848x848px. Retinal fundus photograph. Graded on the modified Davis scale
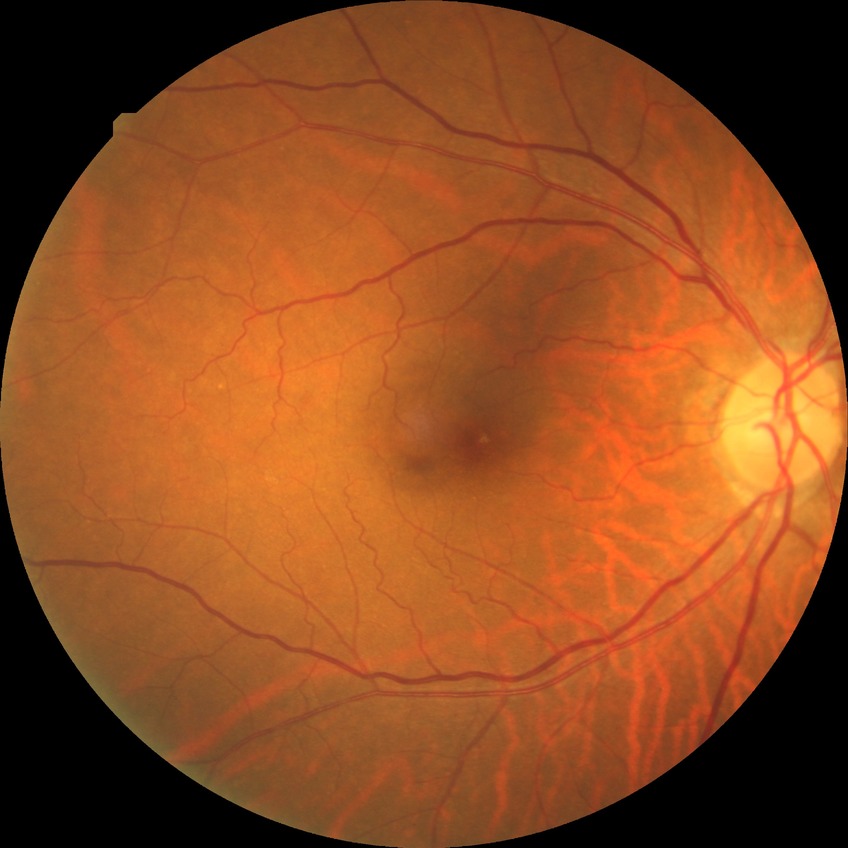
modified Davis grade=SDR.